Field includes the optic disc and macula: 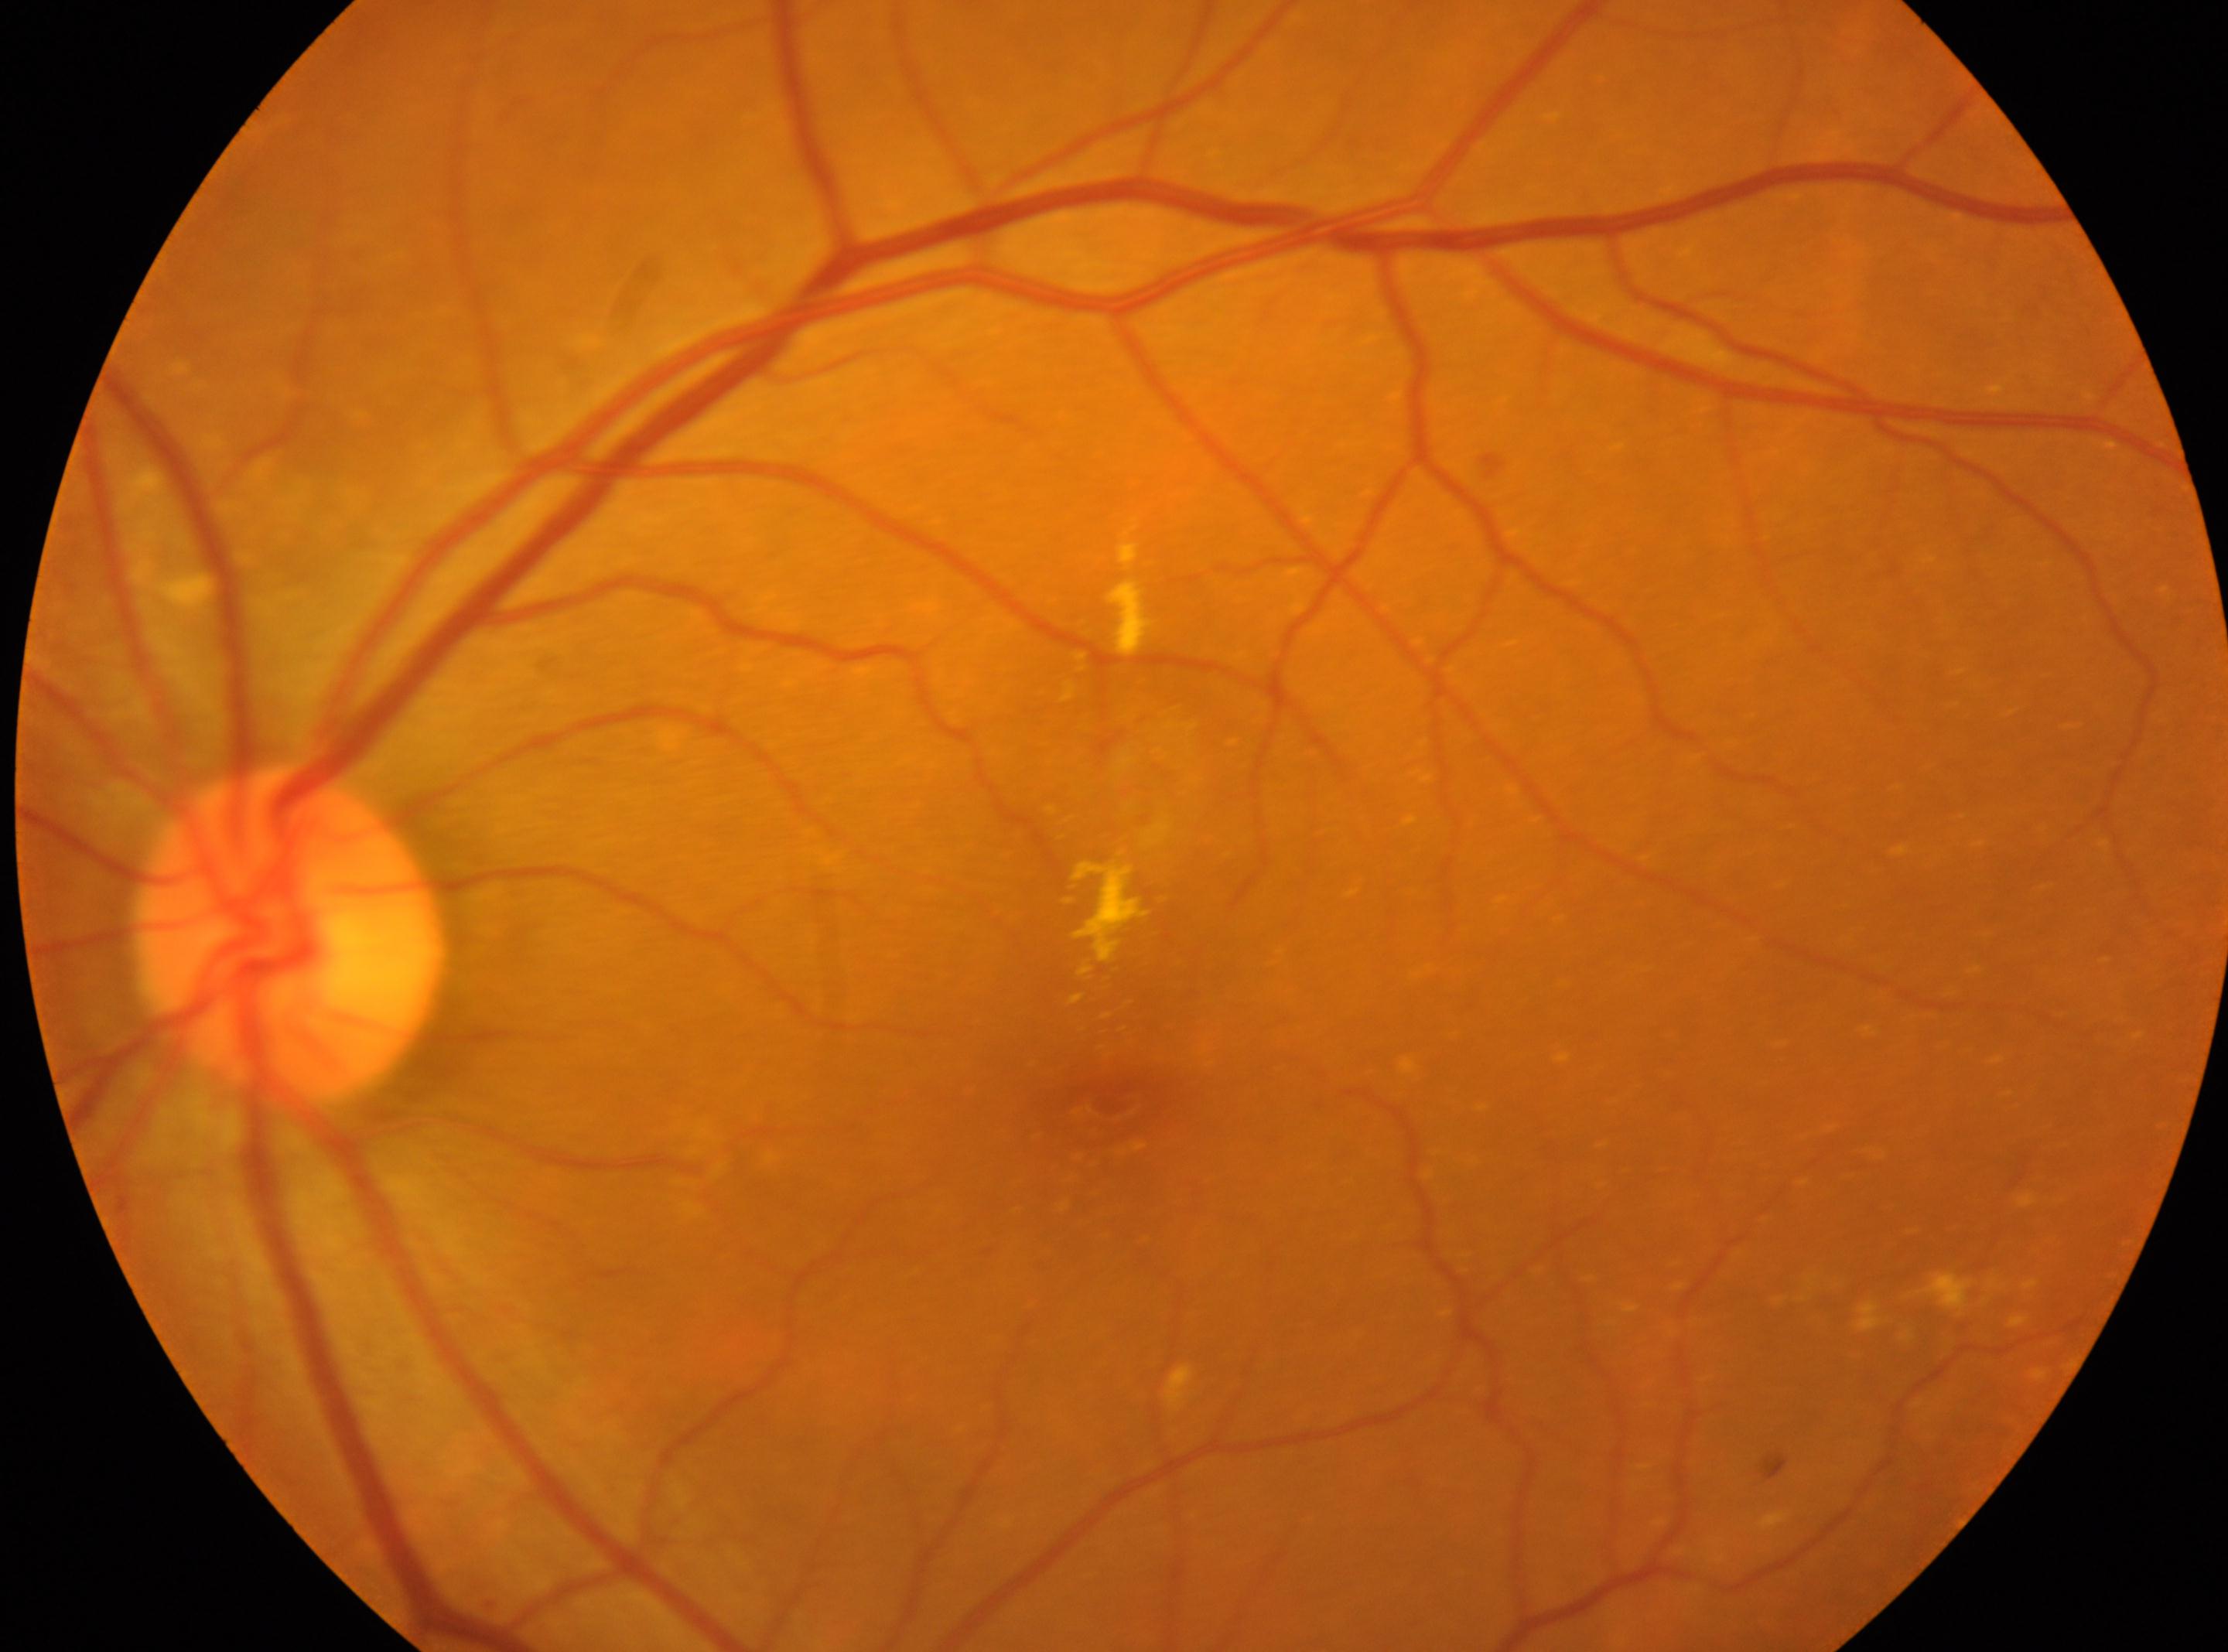

DR class = non-proliferative diabetic retinopathy
eye = OS
macular center = (1109, 1100)
diabetic retinopathy grade = 2 (moderate NPDR)
optic disc center = (288, 936)